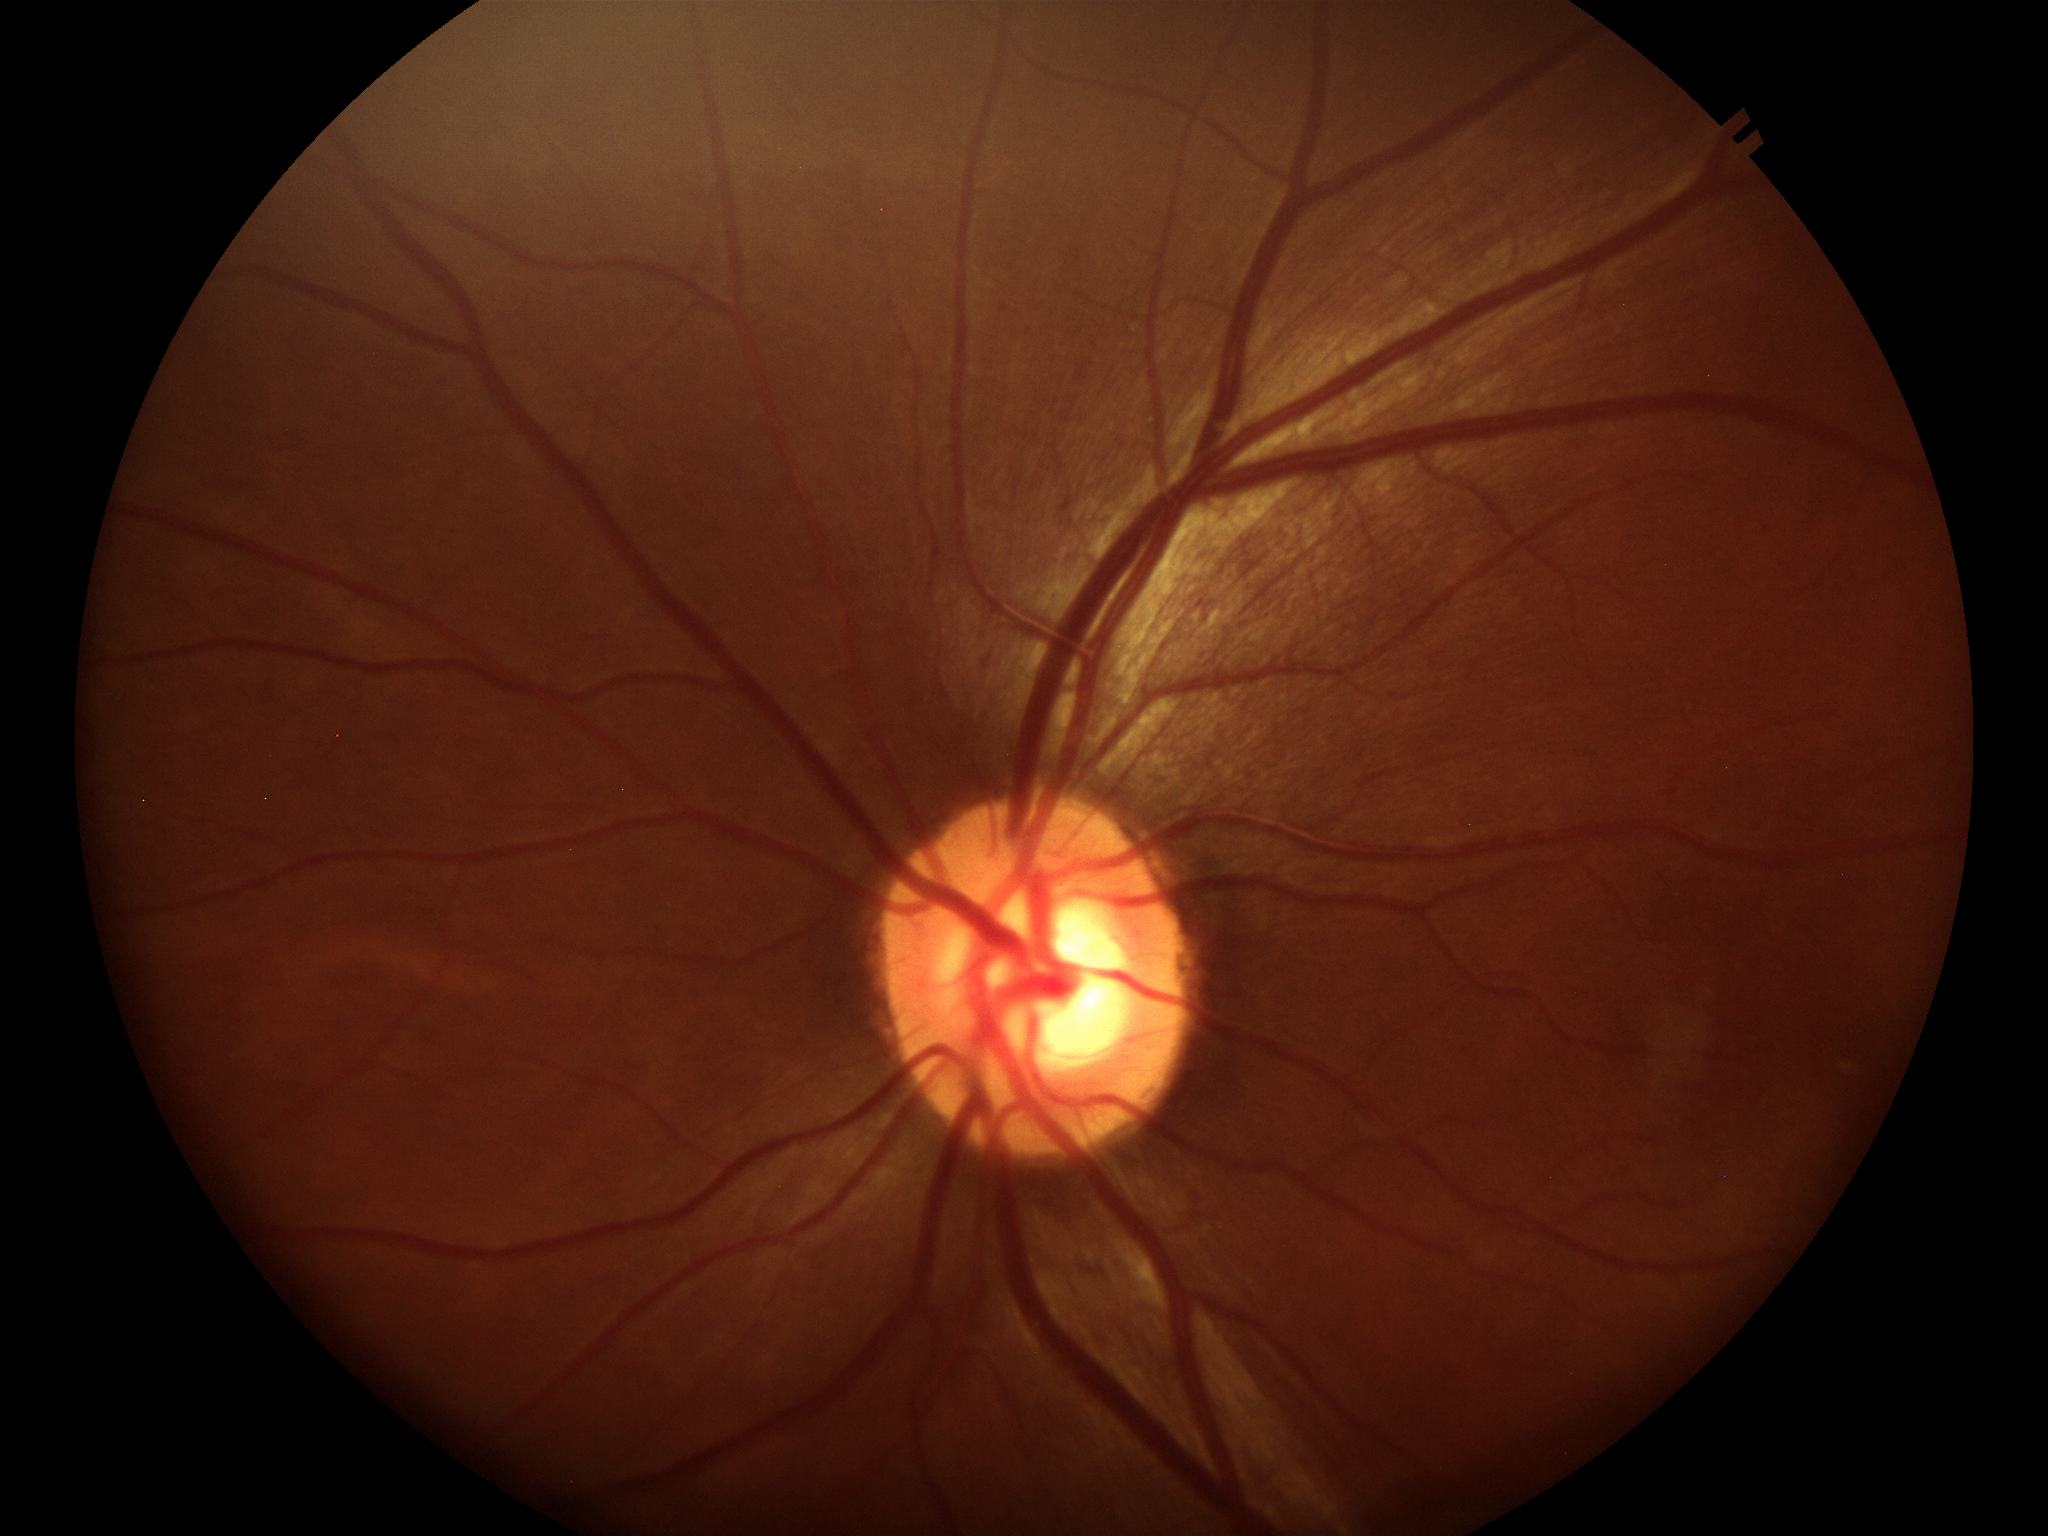 No evidence of glaucoma.
VCDR of 0.59.